848x848px: 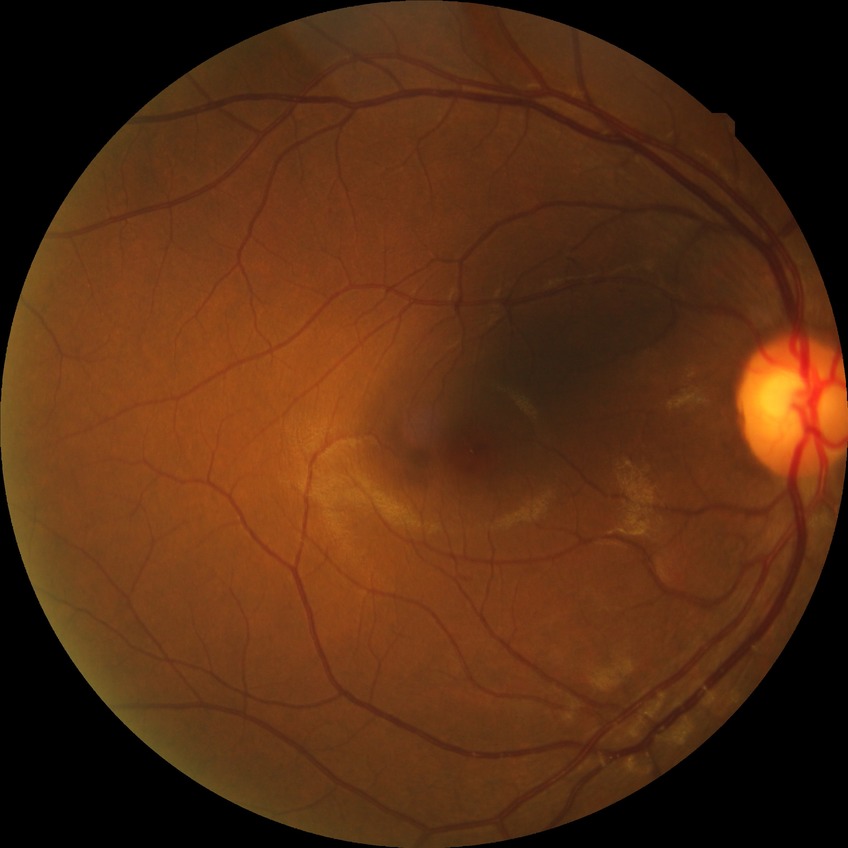 Diabetic retinopathy (DR): simple diabetic retinopathy (SDR).